45 degree fundus photograph, modified Davis grading:
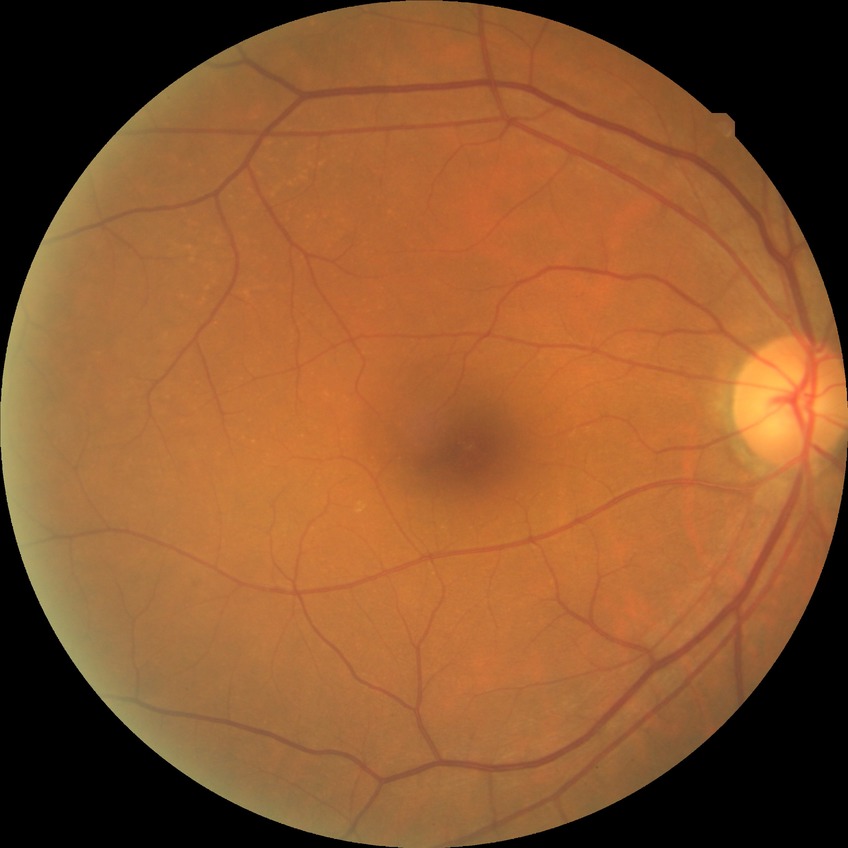 retinopathy grade: no diabetic retinopathy.